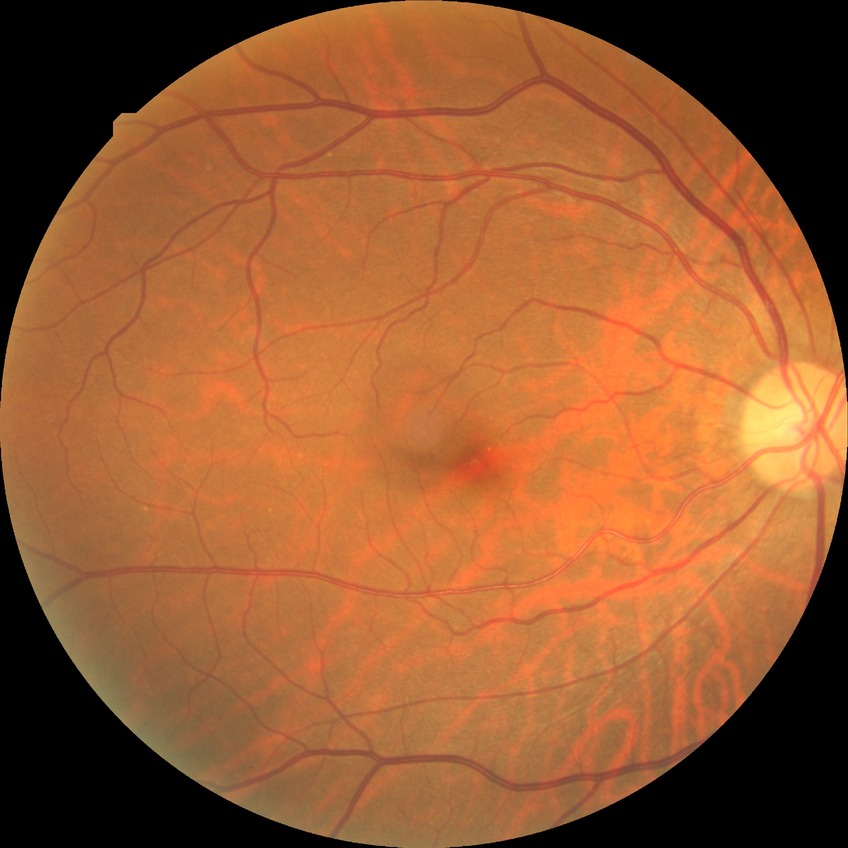

Diabetic retinopathy (DR): NDR (no diabetic retinopathy).